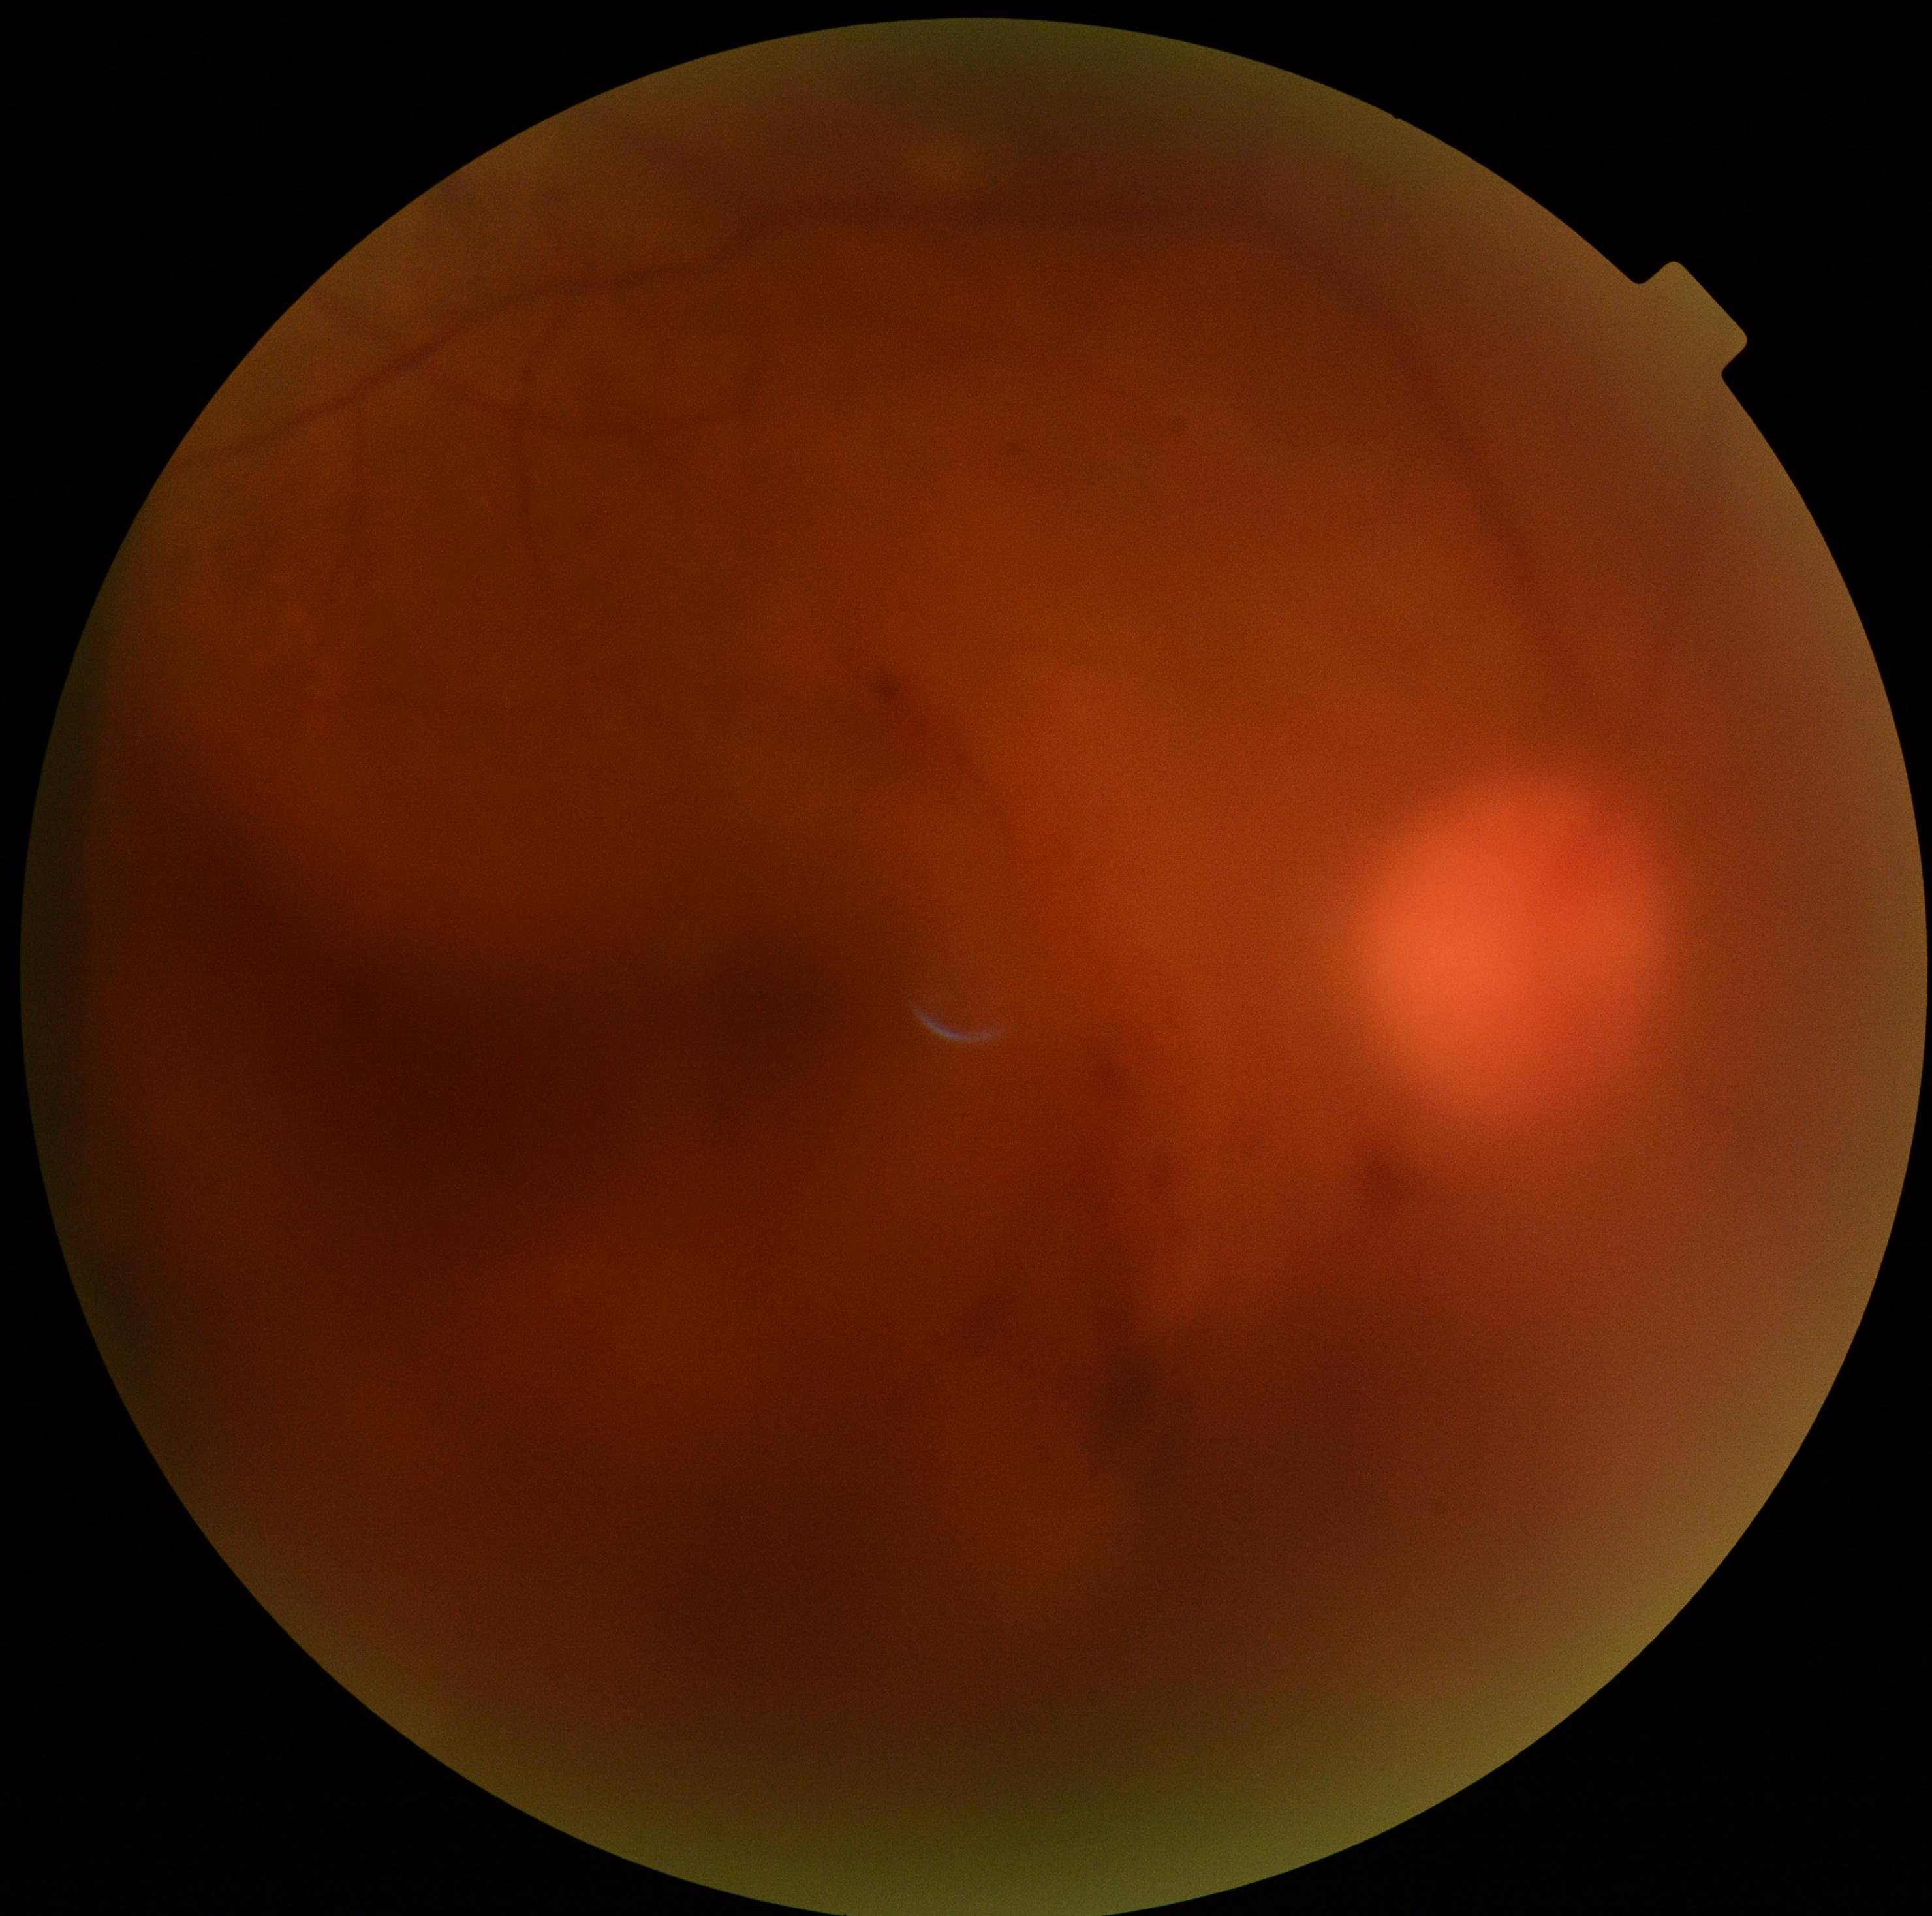

diabetic retinopathy (DR): grade 4 — neovascularization and/or vitreous/pre-retinal hemorrhage.